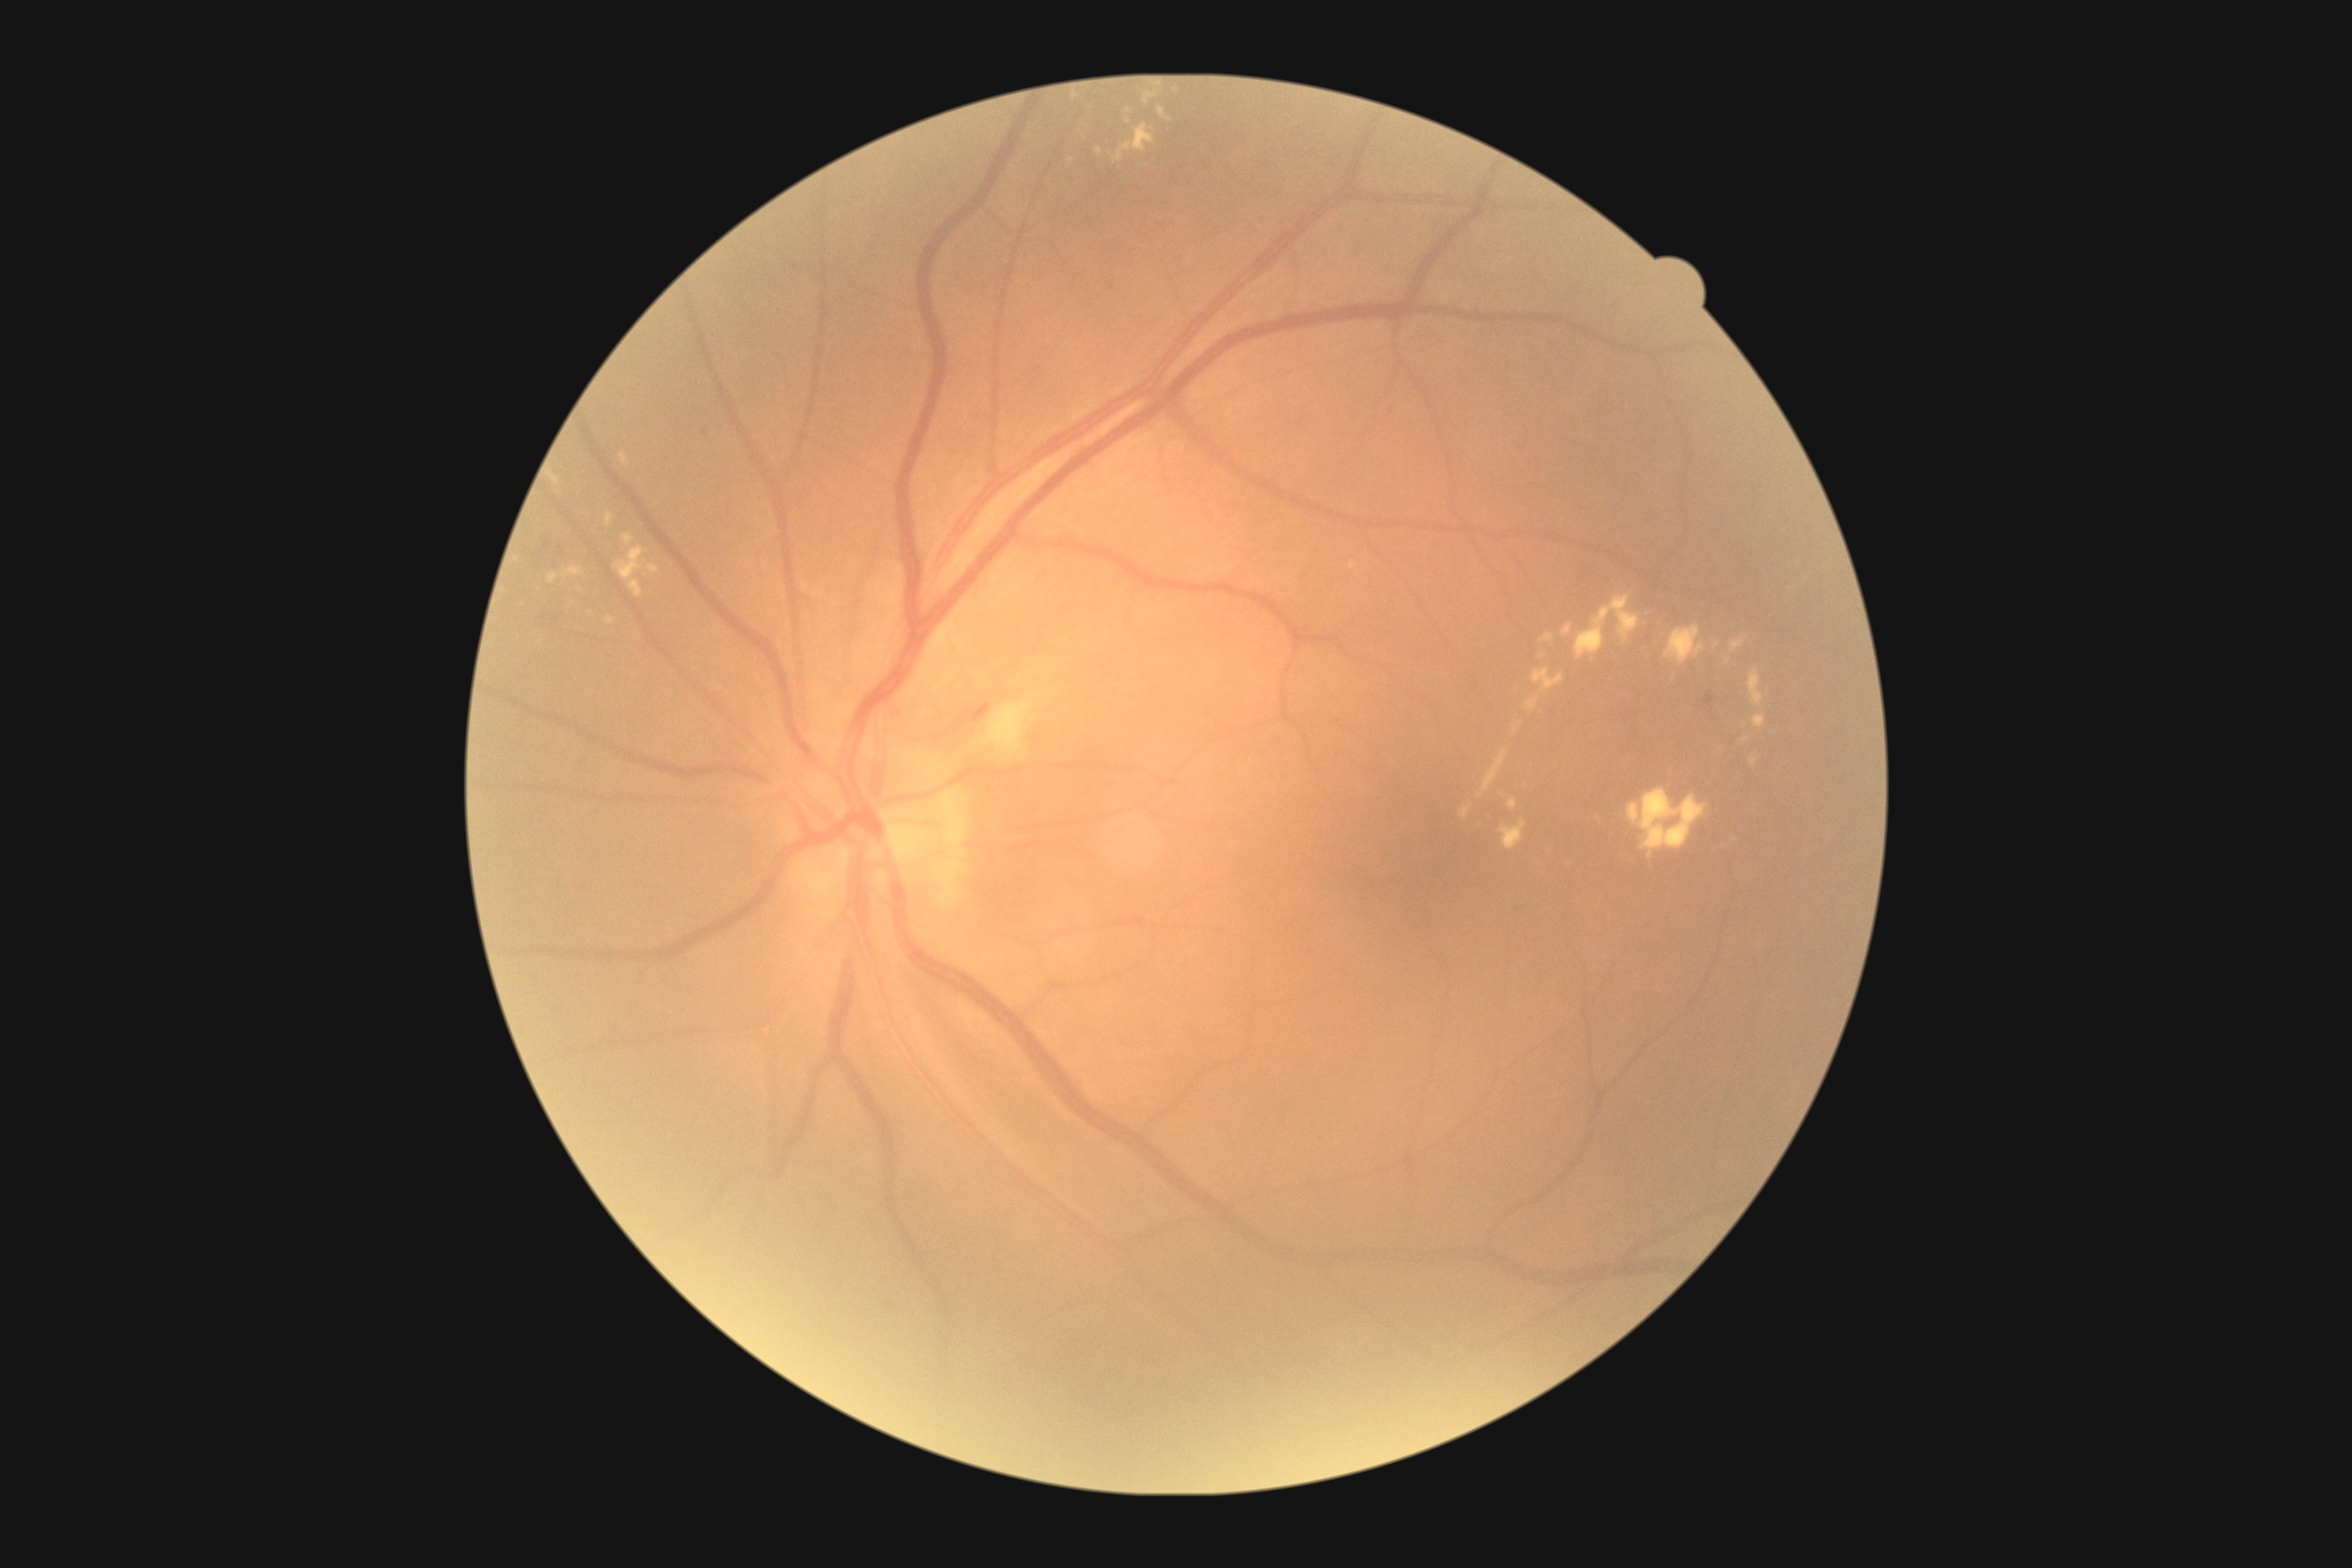 Diabetic retinopathy (DR): grade 2 (moderate NPDR).